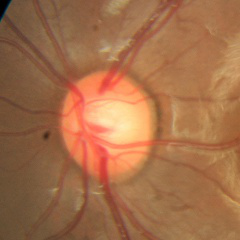 Diagnosis = no glaucomatous optic neuropathy.